Wide-field fundus photograph from neonatal ROP screening: 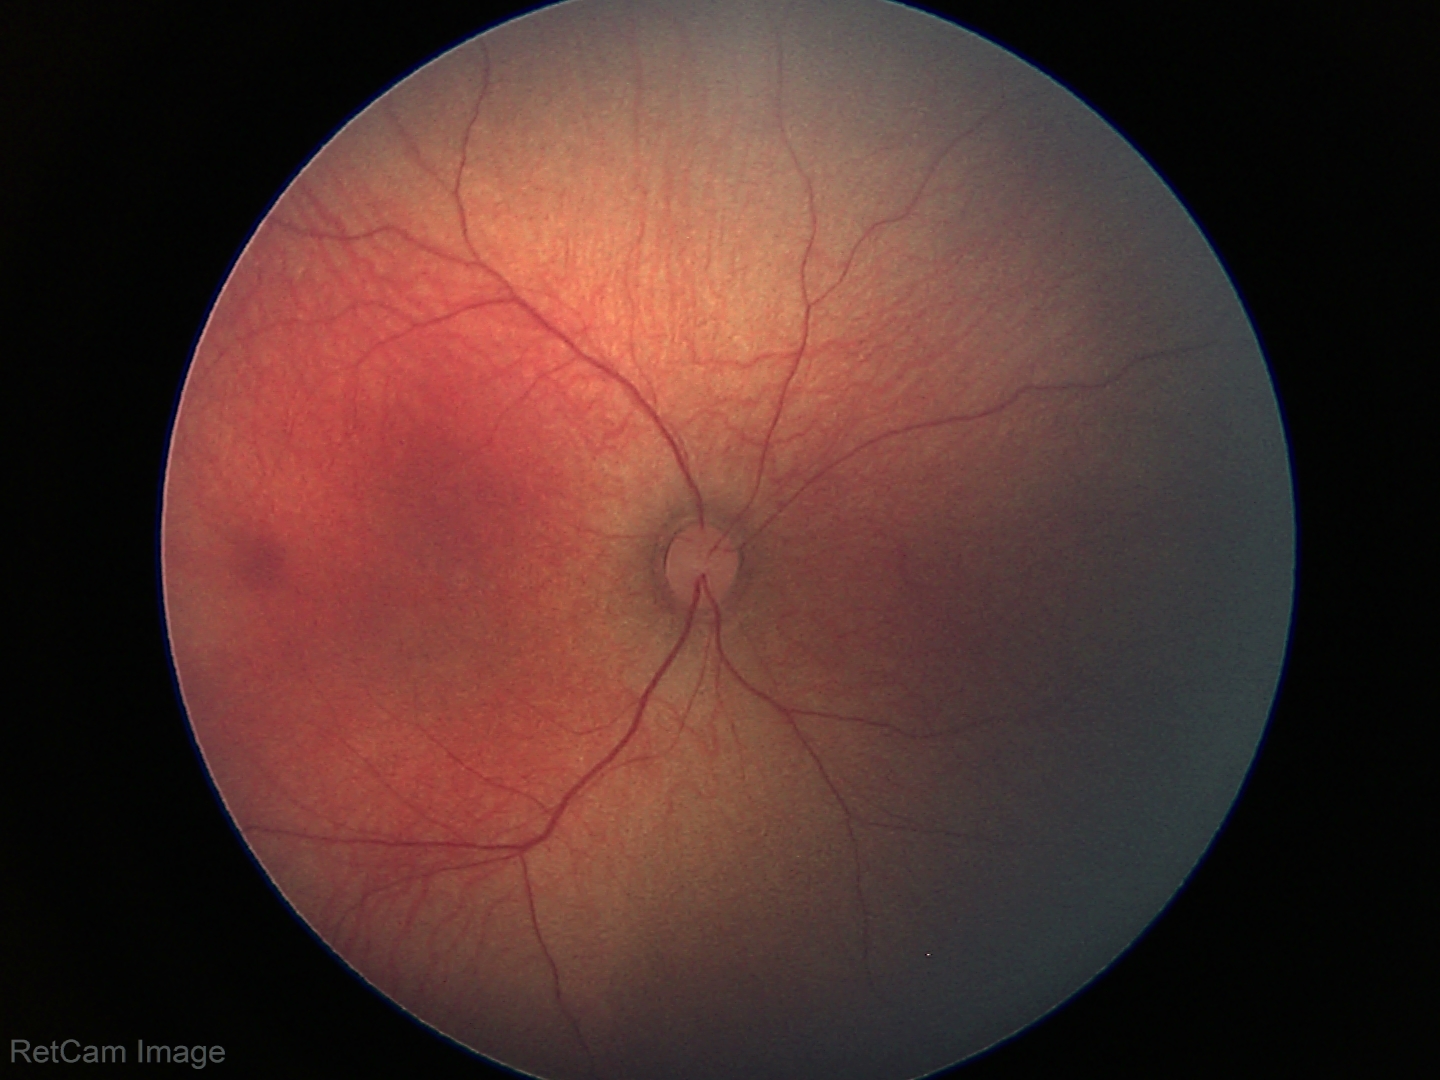

Q: What is the screening diagnosis?
A: physiological finding